Wide-field fundus image from infant ROP screening — 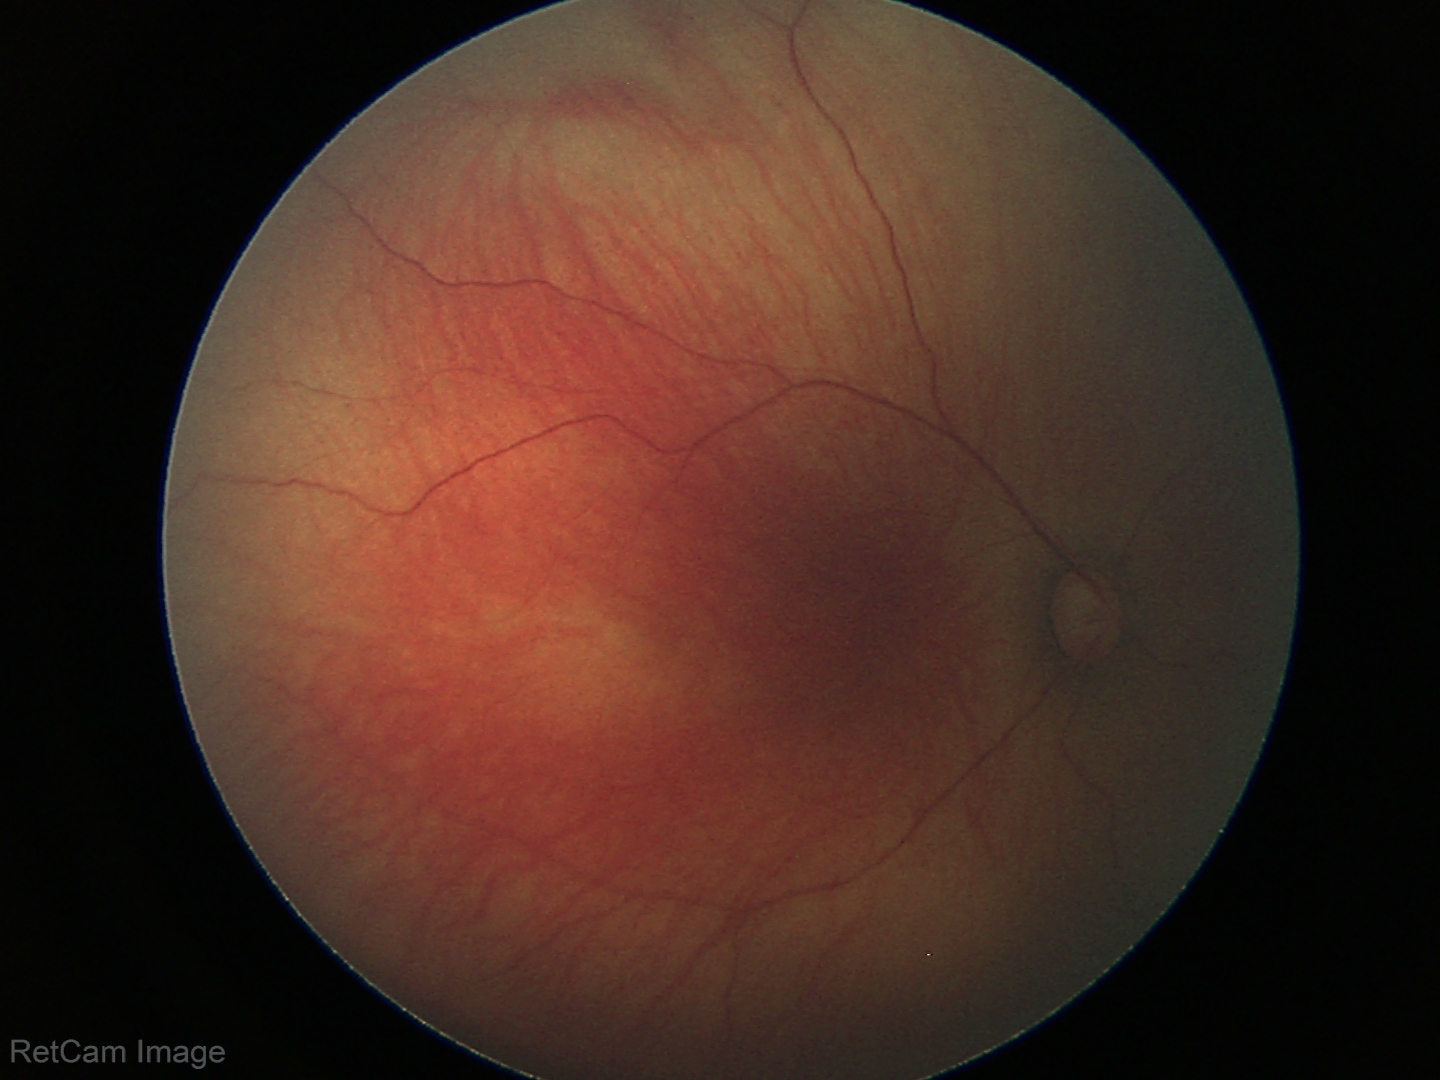

Examination with physiological retinal findings.